2048x1536px, 45-degree field of view, CFP — 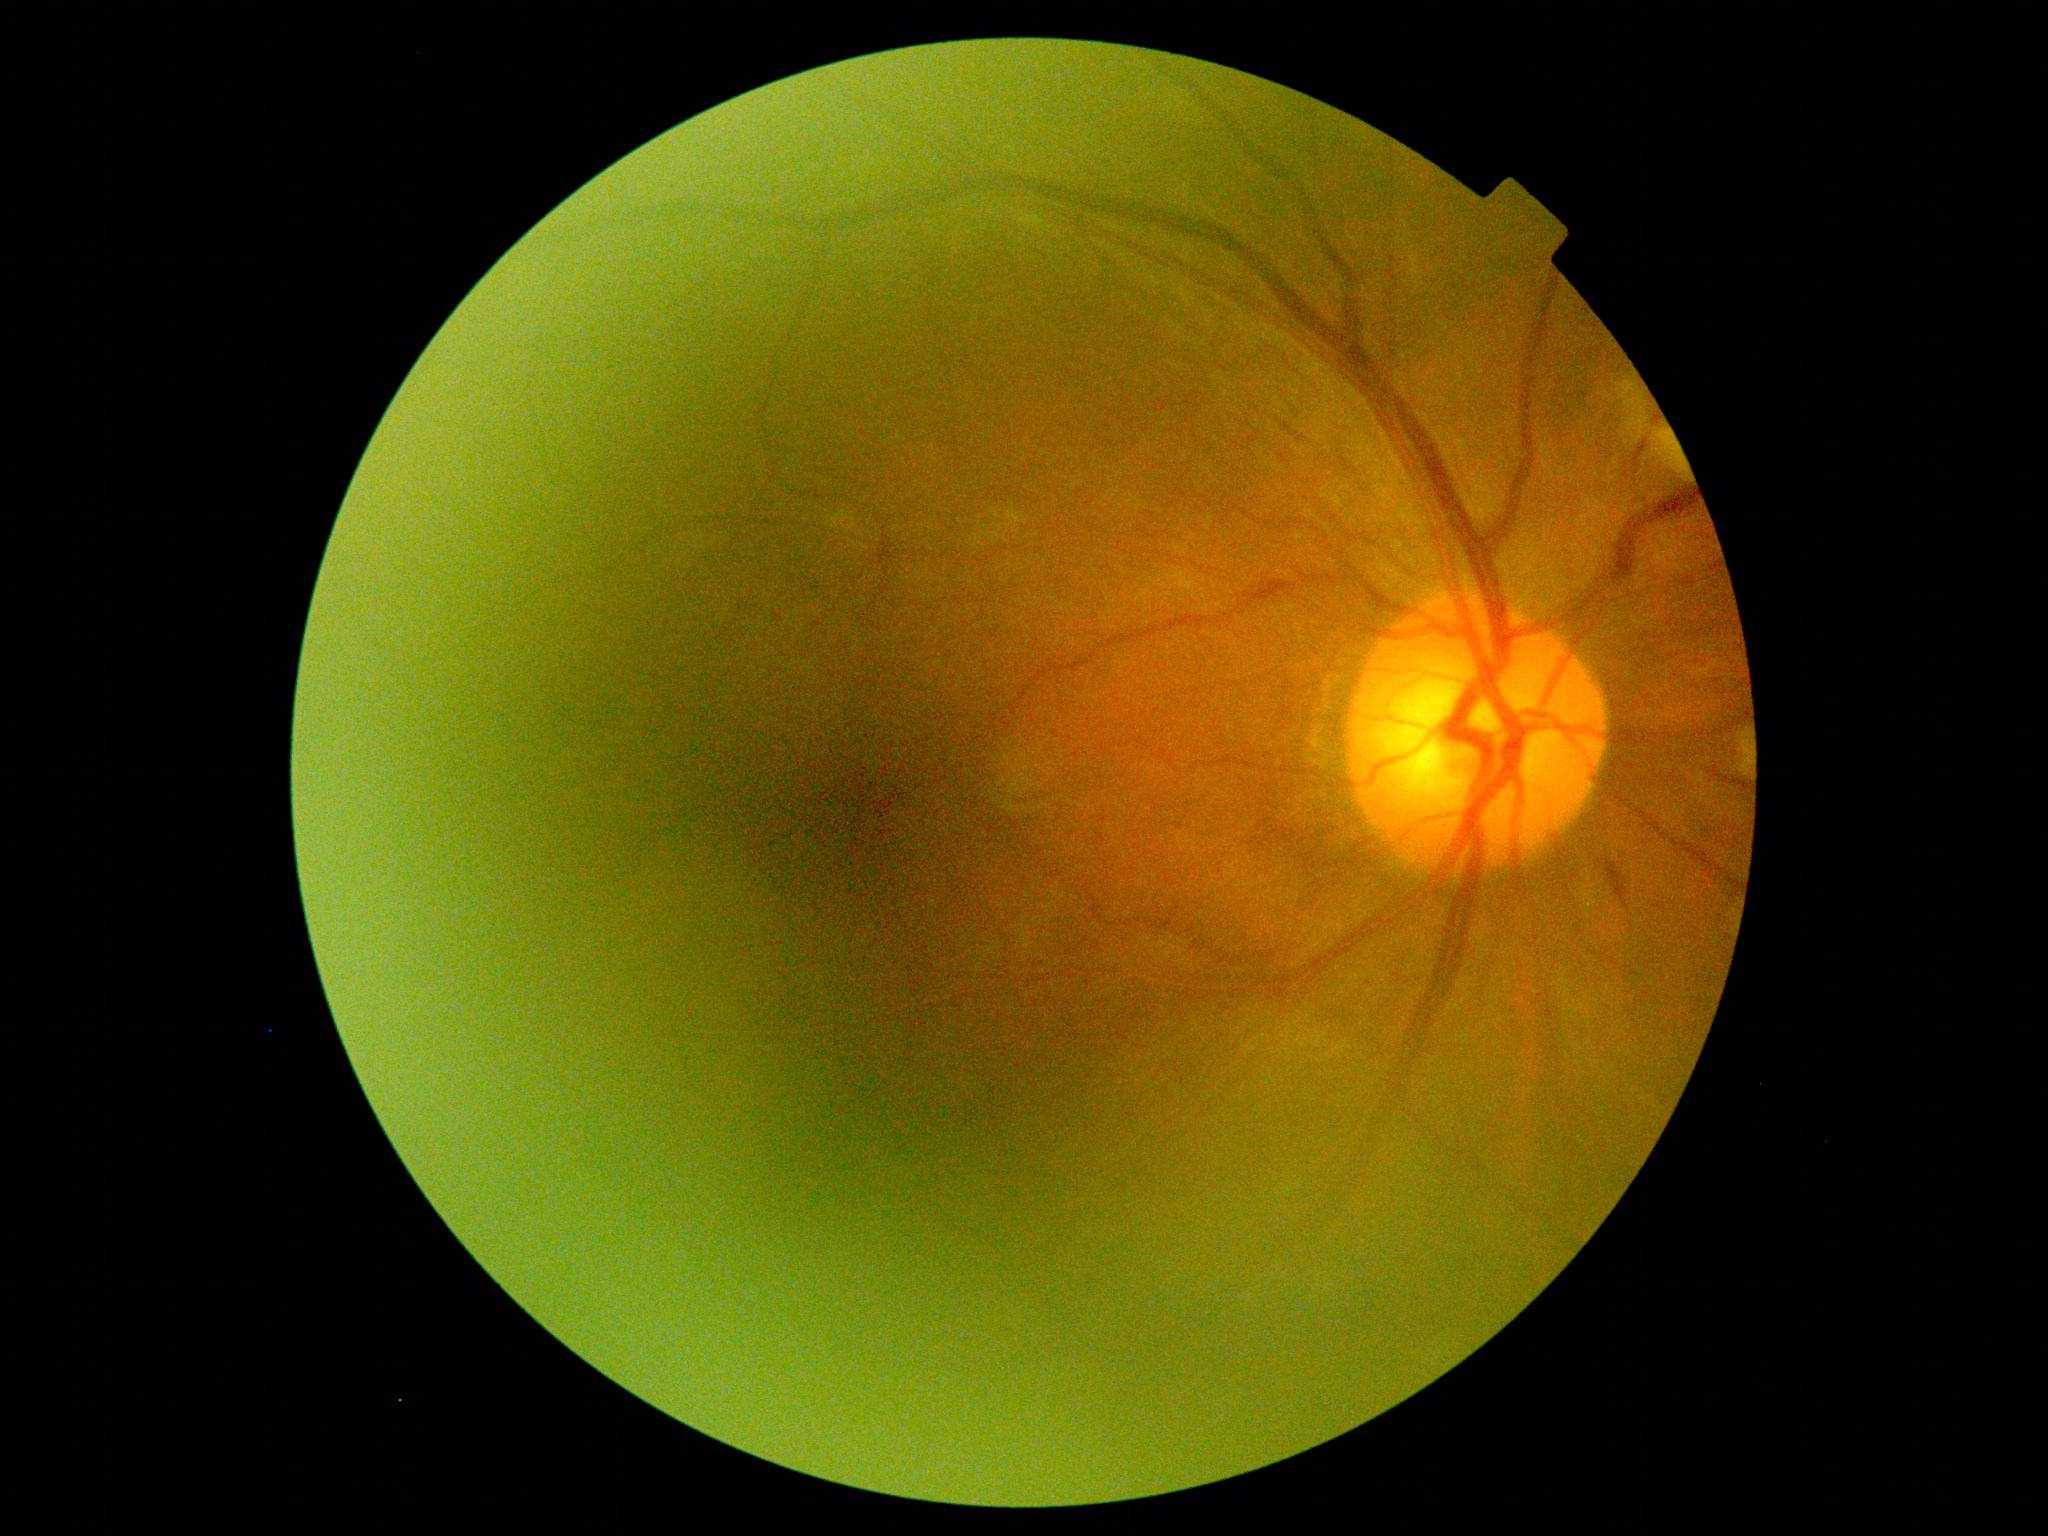 The retinopathy is classified as non-proliferative diabetic retinopathy. DR is moderate non-proliferative diabetic retinopathy (grade 2).